No pharmacologic dilation
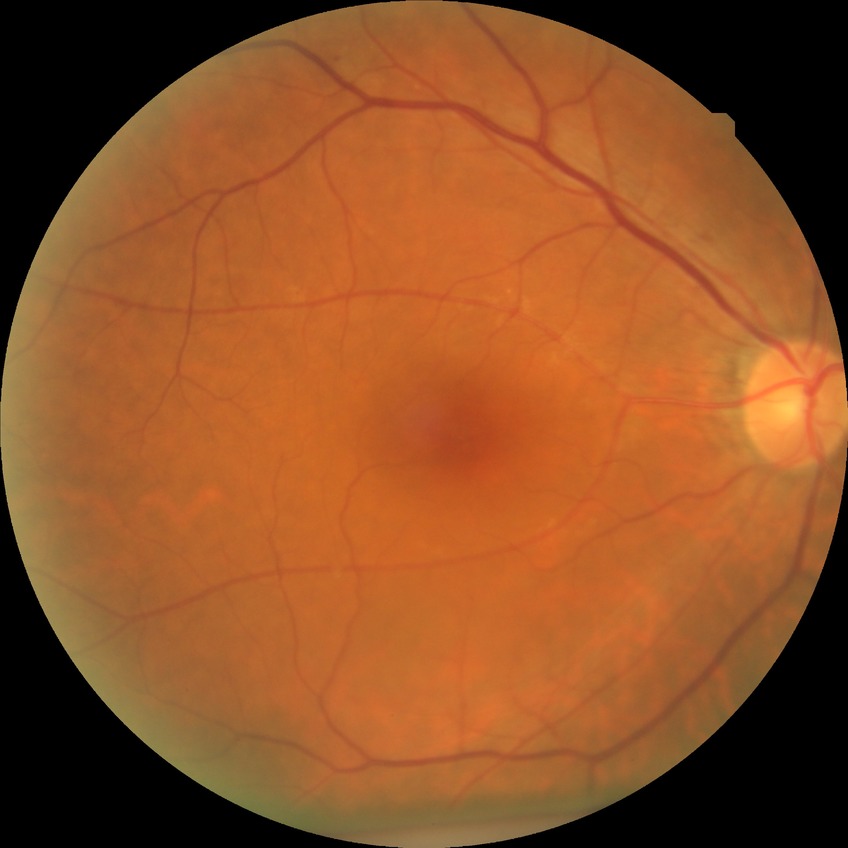 Diabetic retinopathy (DR) is NDR (no diabetic retinopathy).